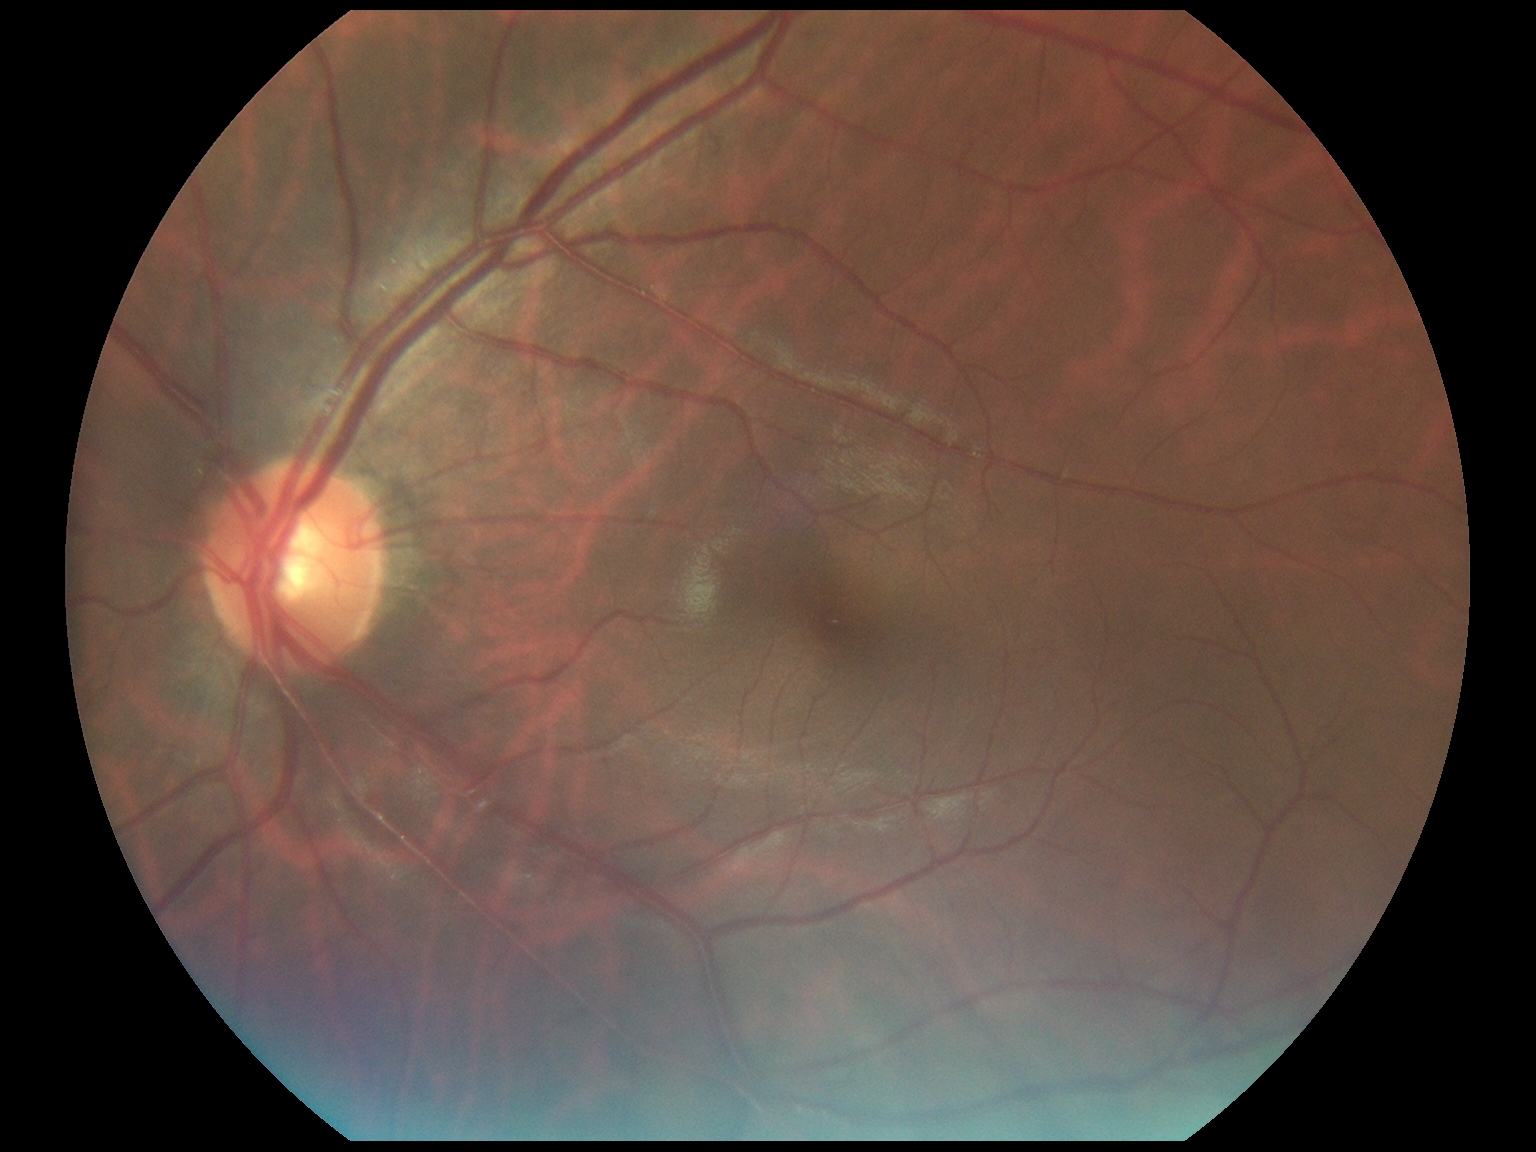 DR grade is no apparent retinopathy (0).